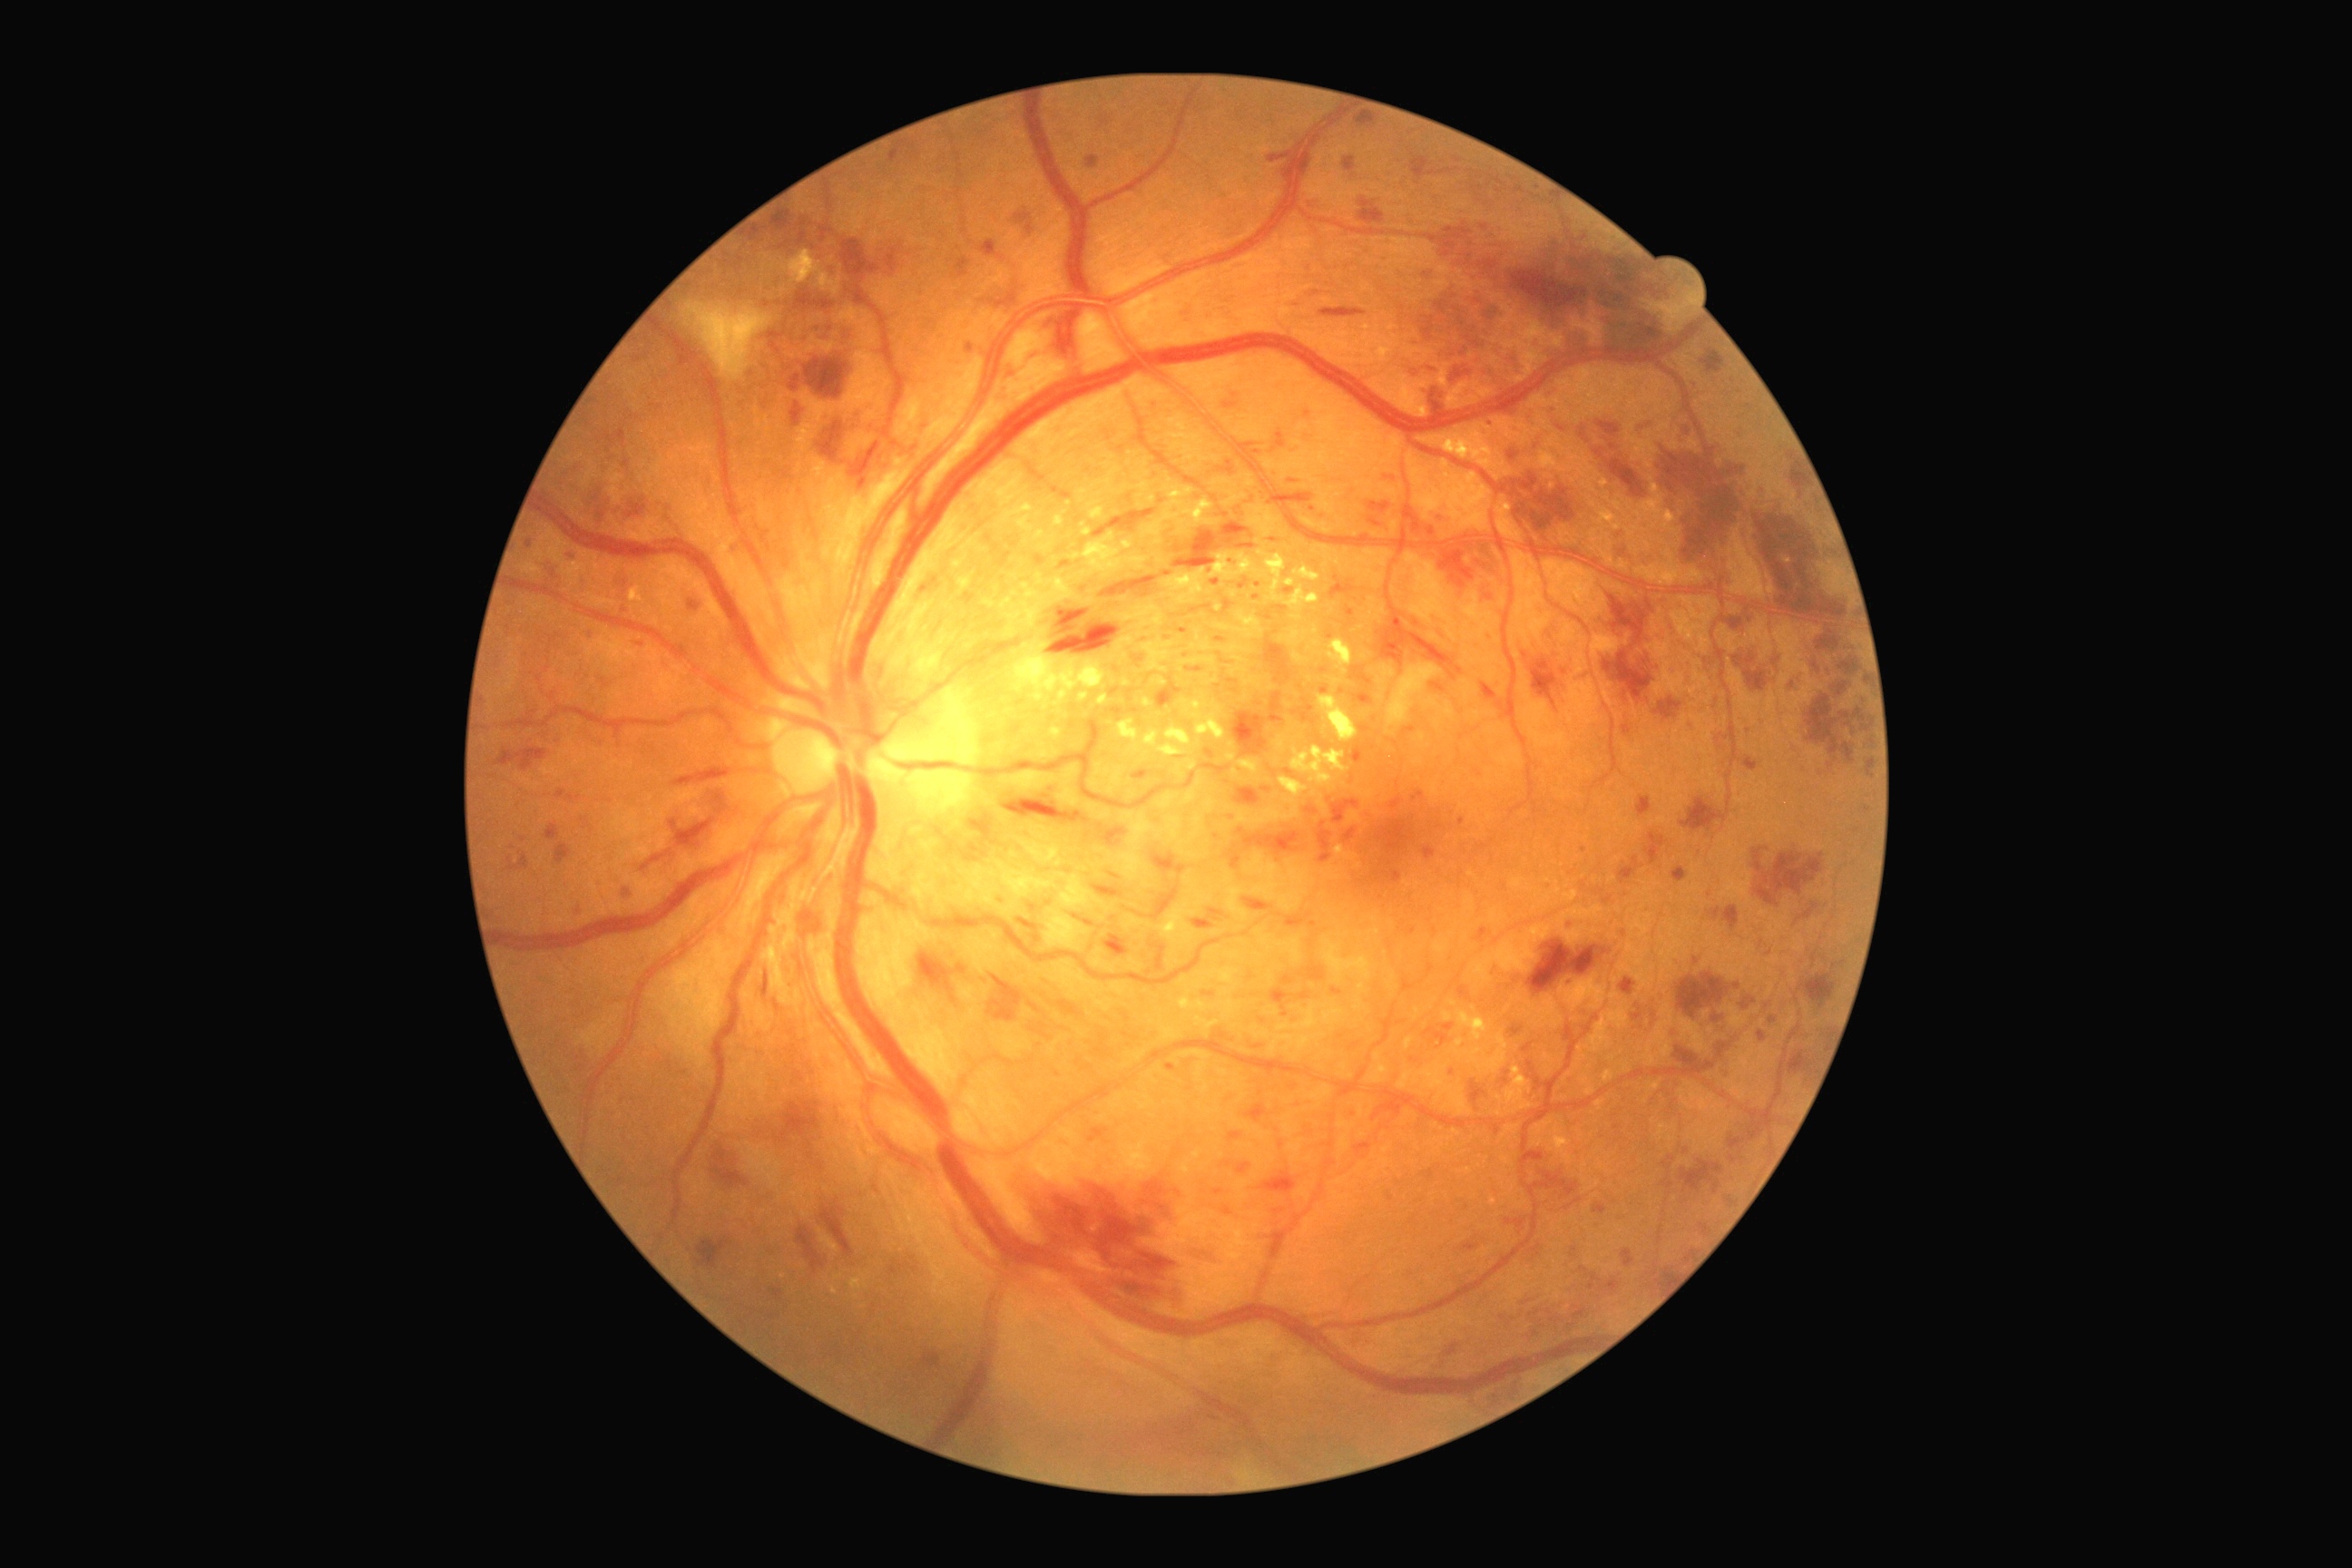

Diabetic retinopathy grade is 3; non-proliferative diabetic retinopathy
Representative lesions:
microaneurysms (subset) = (x1=1166, y1=1064, x2=1175, y2=1072); (x1=1574, y1=1309, x2=1587, y2=1318); (x1=1741, y1=997, x2=1756, y2=1010); (x1=1424, y1=1028, x2=1449, y2=1046); (x1=1217, y1=460, x2=1235, y2=476); (x1=1179, y1=629, x2=1188, y2=634); (x1=1424, y1=271, x2=1433, y2=282); (x1=1128, y1=691, x2=1133, y2=701); (x1=1614, y1=1124, x2=1622, y2=1130); (x1=1268, y1=153, x2=1289, y2=162); (x1=1282, y1=975, x2=1295, y2=986); (x1=1306, y1=807, x2=1317, y2=814); (x1=1353, y1=692, x2=1373, y2=705); (x1=1012, y1=725, x2=1021, y2=734)
Small microaneurysms near 1292, 482; 1236, 395; 1135, 711; 1769, 954; 1186, 656
hard exudates (subset) = (x1=1088, y1=502, x2=1104, y2=520); (x1=1289, y1=747, x2=1349, y2=789); (x1=985, y1=600, x2=995, y2=609); (x1=1035, y1=531, x2=1044, y2=540); (x1=1284, y1=580, x2=1295, y2=587); (x1=1186, y1=760, x2=1199, y2=770); (x1=1284, y1=701, x2=1293, y2=709); (x1=954, y1=534, x2=981, y2=569); (x1=1211, y1=549, x2=1286, y2=603); (x1=1293, y1=651, x2=1309, y2=665); (x1=1113, y1=603, x2=1164, y2=629); (x1=1117, y1=720, x2=1141, y2=741)
Small hard exudates near 1311, 679; 1113, 659; 1182, 670; 1194, 648; 1233, 594
hemorrhages (subset) = (x1=1344, y1=157, x2=1355, y2=173); (x1=917, y1=952, x2=966, y2=992); (x1=1269, y1=495, x2=1378, y2=549); (x1=1048, y1=609, x2=1121, y2=656); (x1=1672, y1=867, x2=1689, y2=883); (x1=1801, y1=974, x2=1836, y2=1008); (x1=1318, y1=821, x2=1333, y2=863); (x1=671, y1=819, x2=716, y2=848); (x1=968, y1=816, x2=992, y2=847); (x1=841, y1=239, x2=881, y2=280); (x1=1260, y1=1171, x2=1297, y2=1195); (x1=1524, y1=652, x2=1529, y2=660); (x1=714, y1=790, x2=730, y2=816); (x1=1102, y1=828, x2=1128, y2=847); (x1=1867, y1=738, x2=1874, y2=752); (x1=1228, y1=845, x2=1242, y2=870); (x1=1818, y1=636, x2=1841, y2=651)
Small hemorrhages near 1848, 725